Camera: NIDEK AFC-230. Image size 848x848. Davis DR grading: 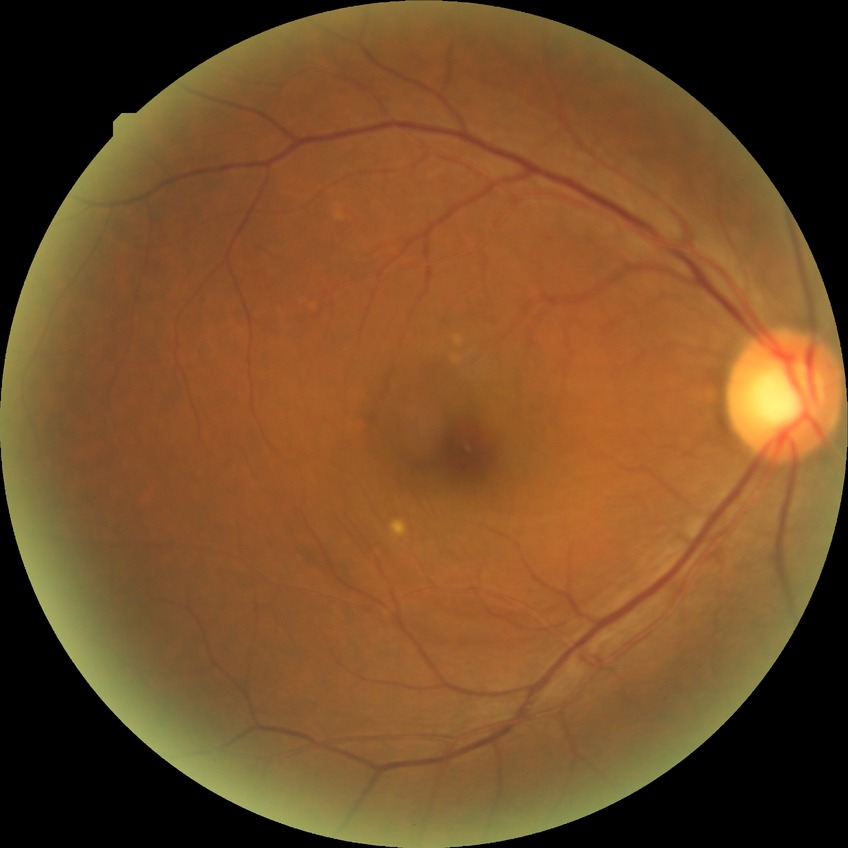

Diabetic retinopathy (DR) is NDR (no diabetic retinopathy).